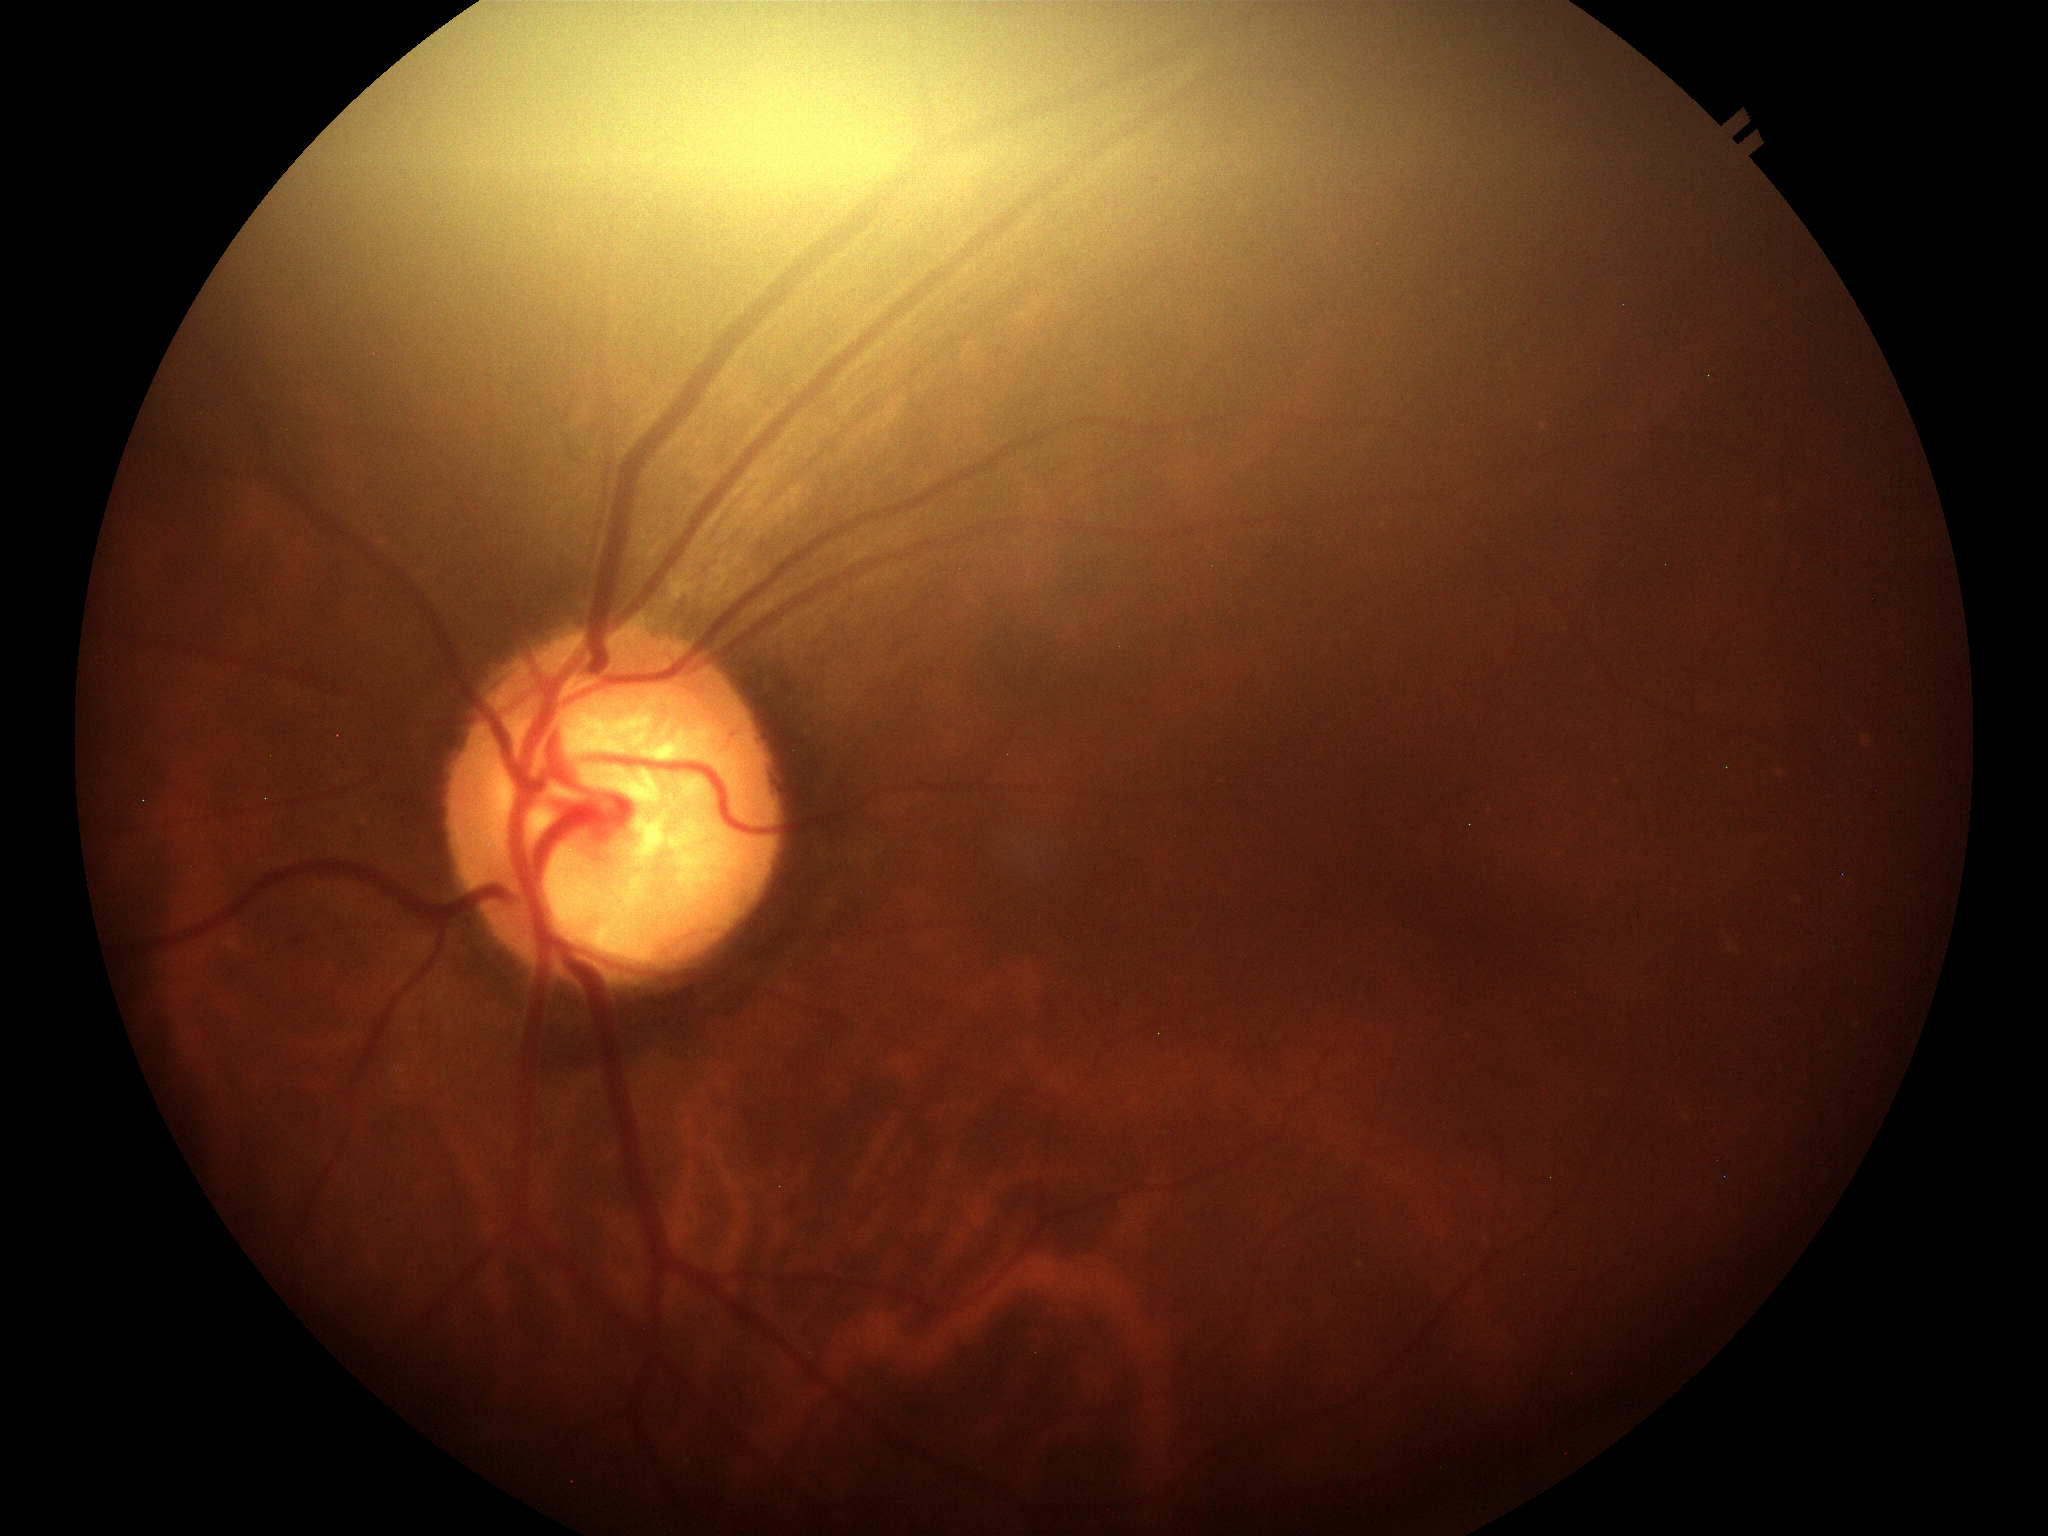 Suspicious for glaucoma. Vertical cup-disc ratio: 0.81.